DR severity per modified Davis staging. 45 degree fundus photograph. NIDEK AFC-230 fundus camera.
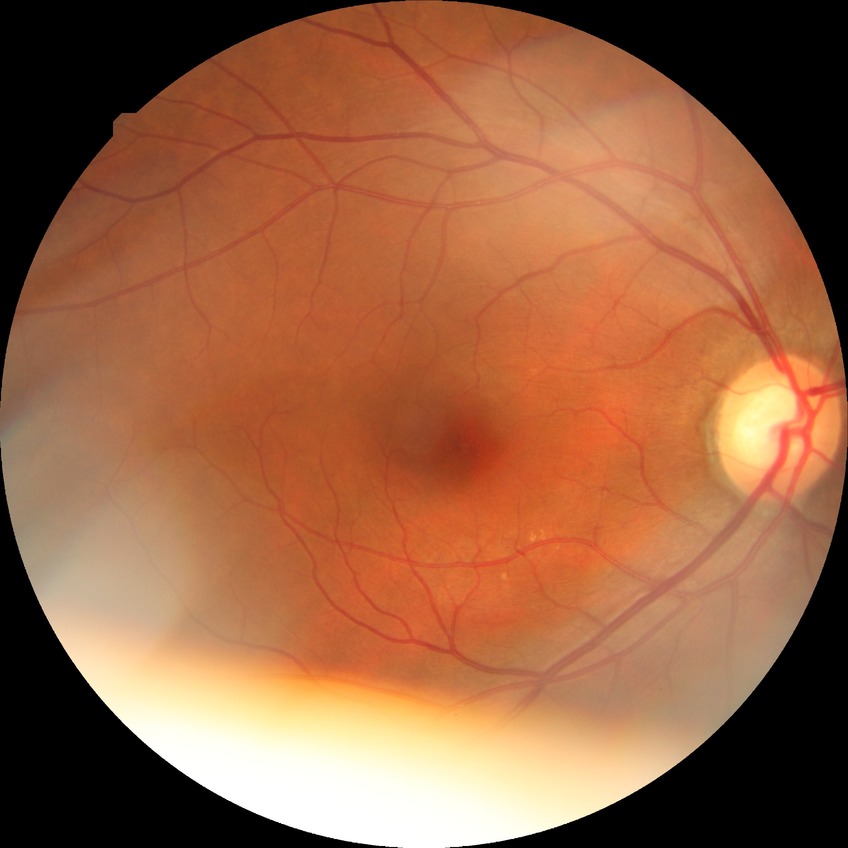

Diabetic retinopathy grade: simple diabetic retinopathy.